Nonmydriatic fundus photograph — 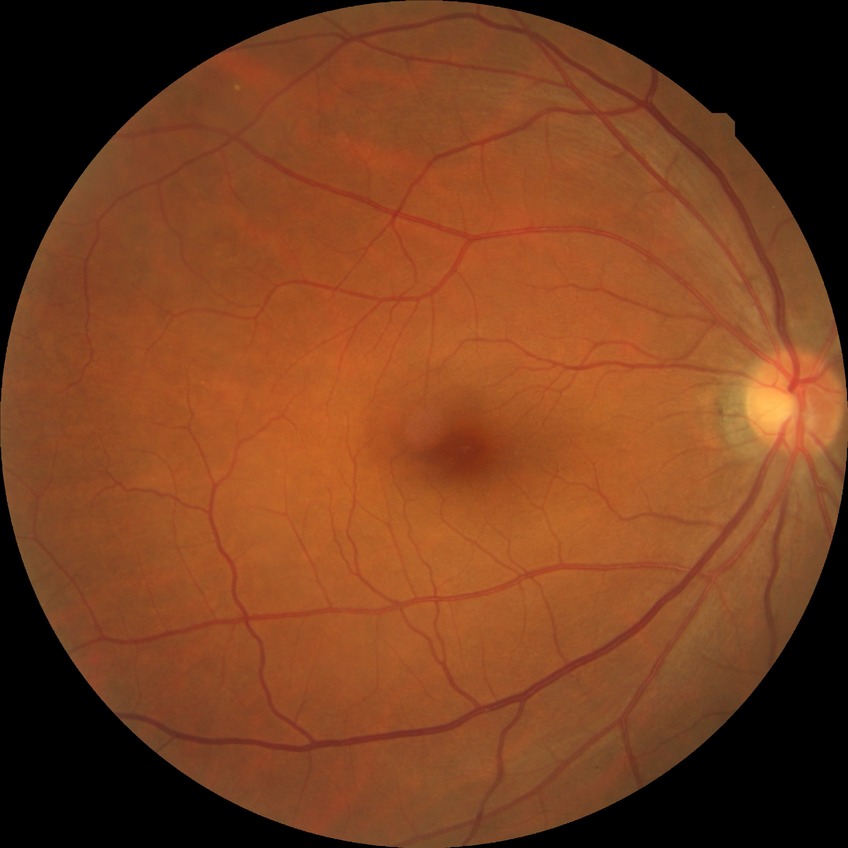
diabetic retinopathy (DR): no diabetic retinopathy (NDR).